848x848px · 45-degree field of view · retinal fundus photograph · NIDEK AFC-230
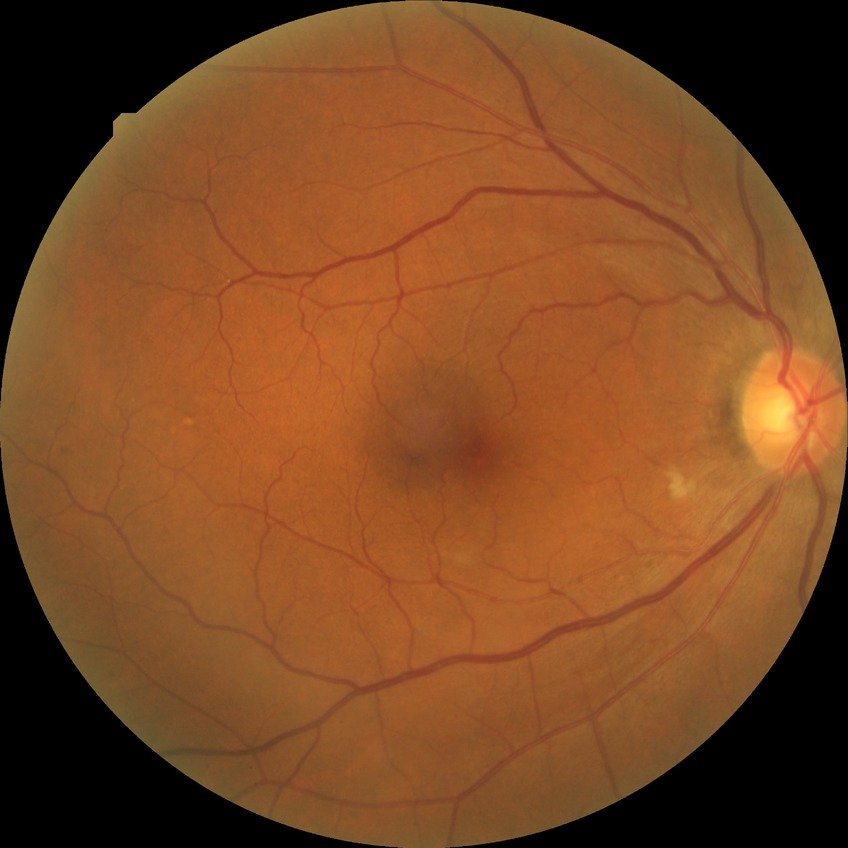 DR class: non-proliferative diabetic retinopathy, diabetic retinopathy (DR): simple diabetic retinopathy (SDR).